240 x 240 pixels; color fundus photograph
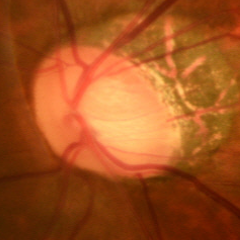 Q: Does this eye have glaucoma?
A: Early-stage glaucoma.